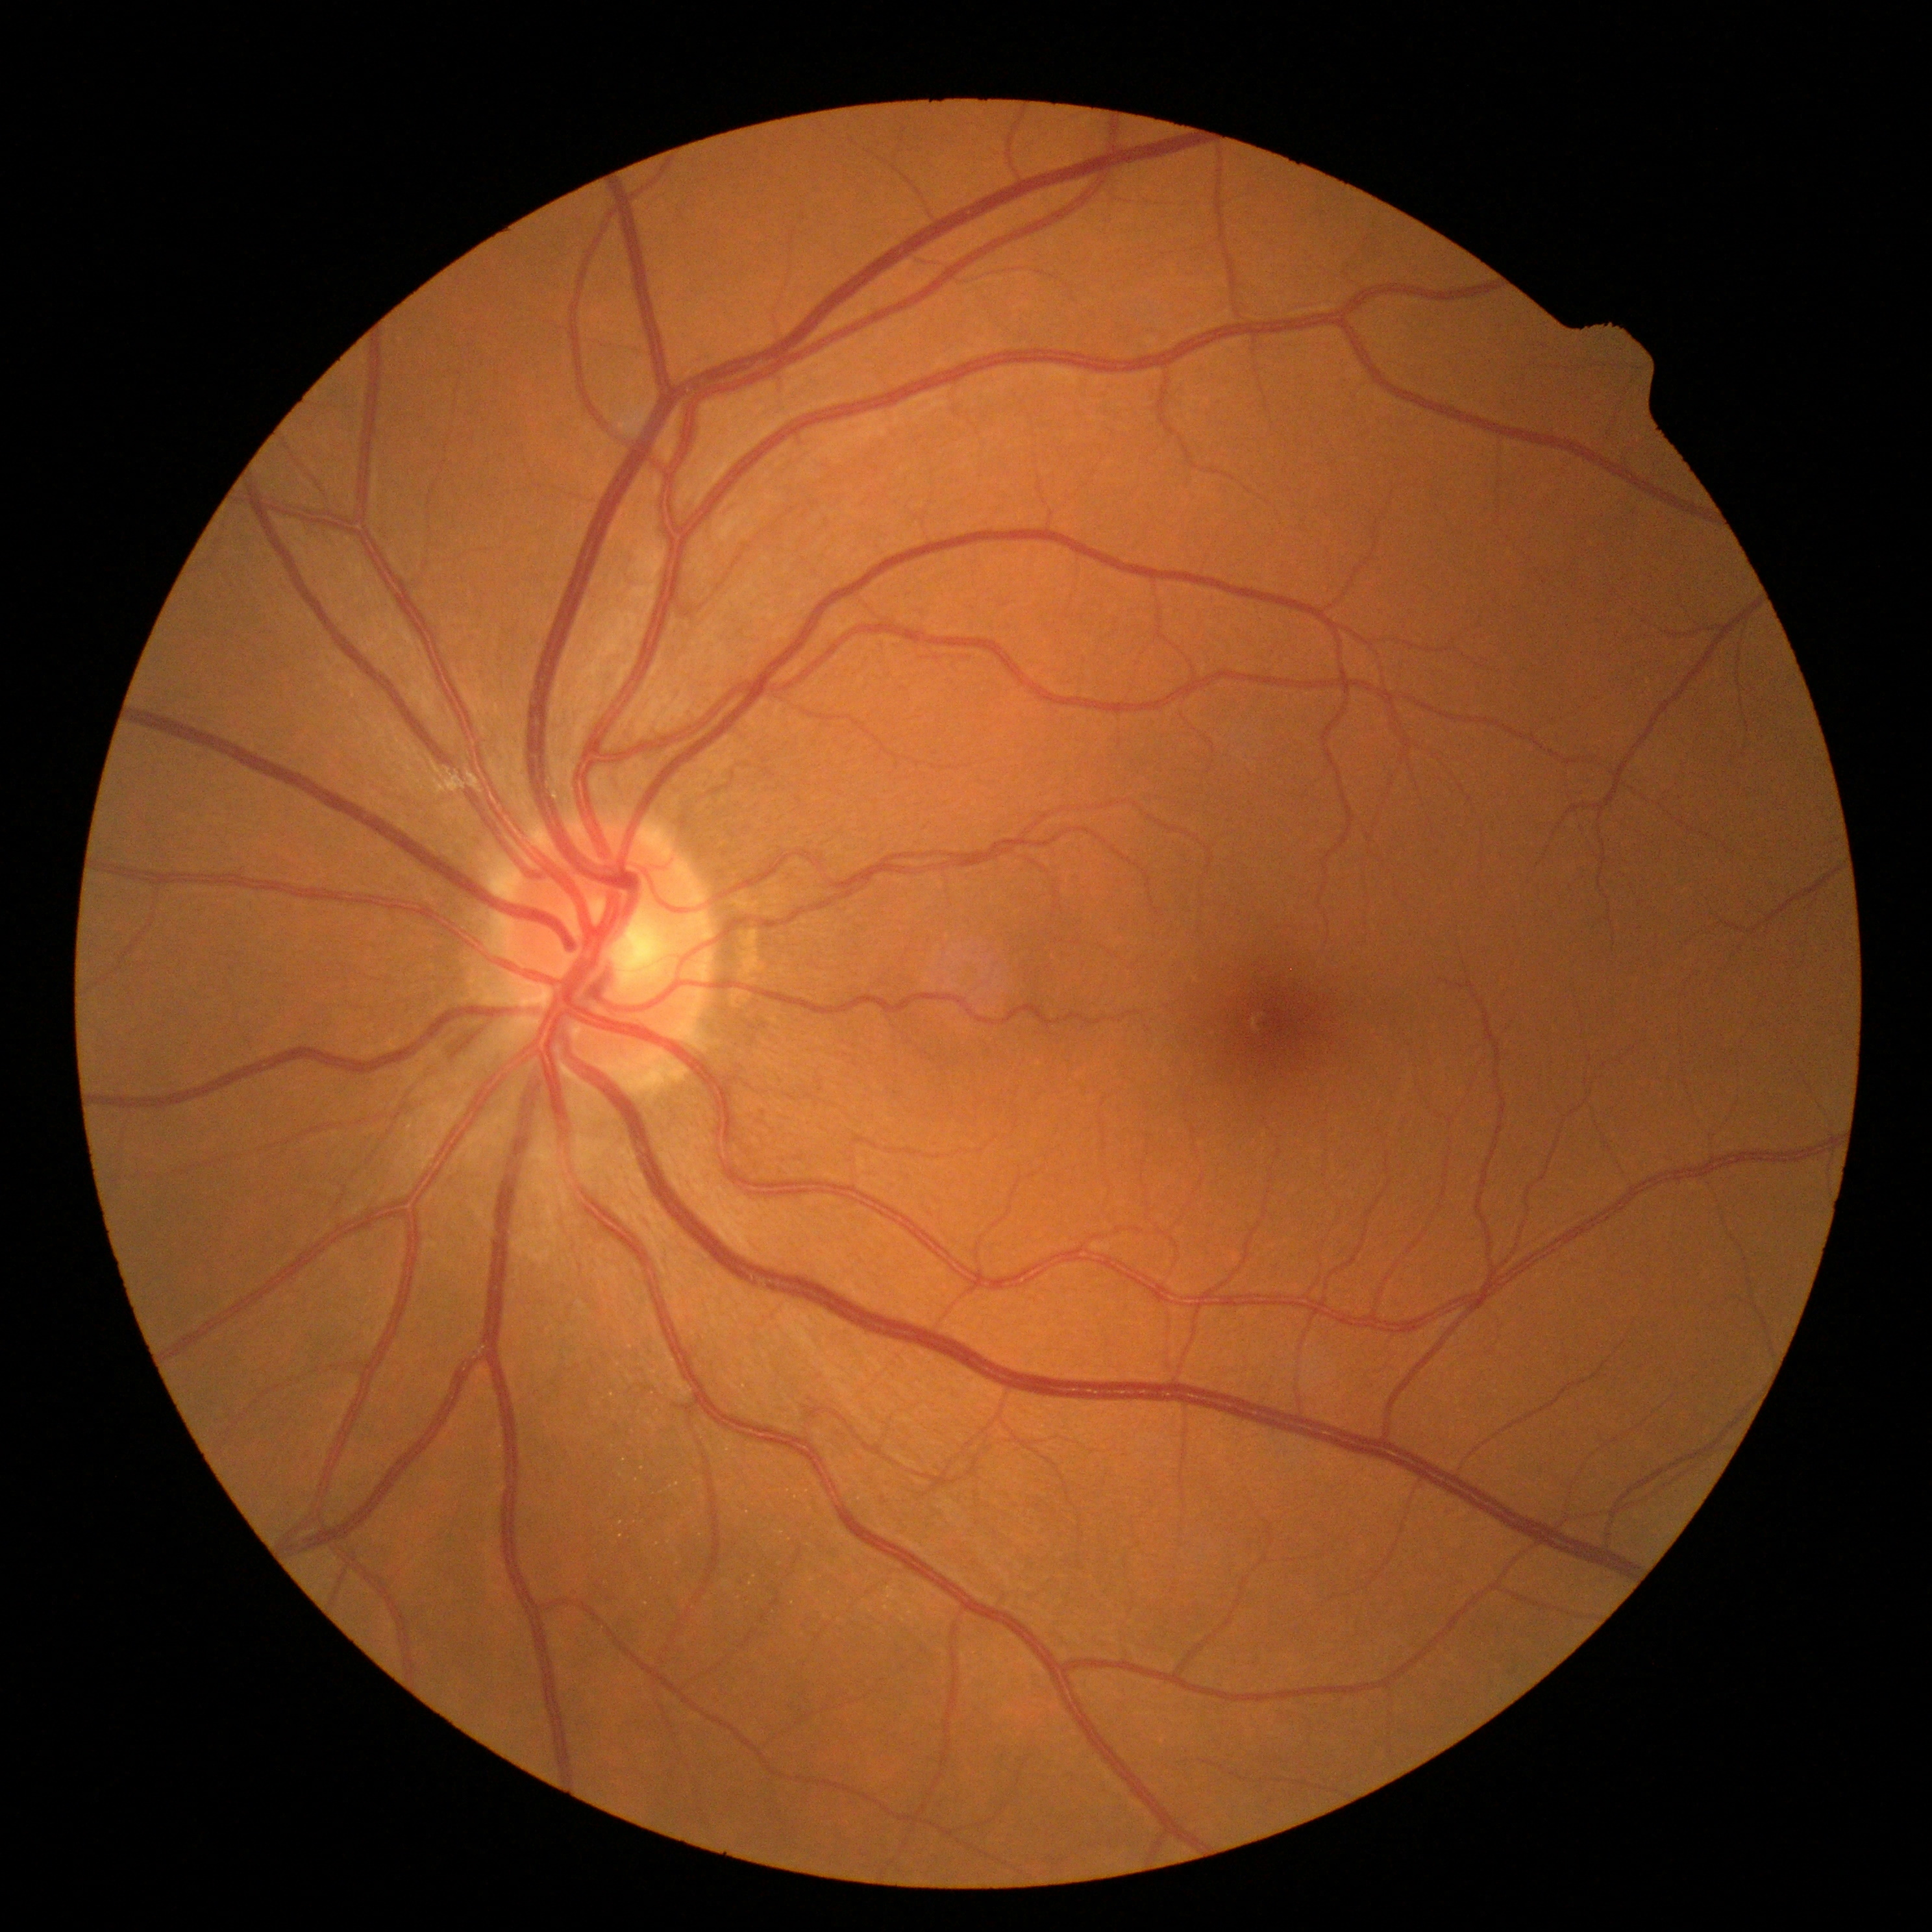

No DR findings.
Diabetic retinopathy: 0/4.